Pediatric retinal photograph (wide-field).
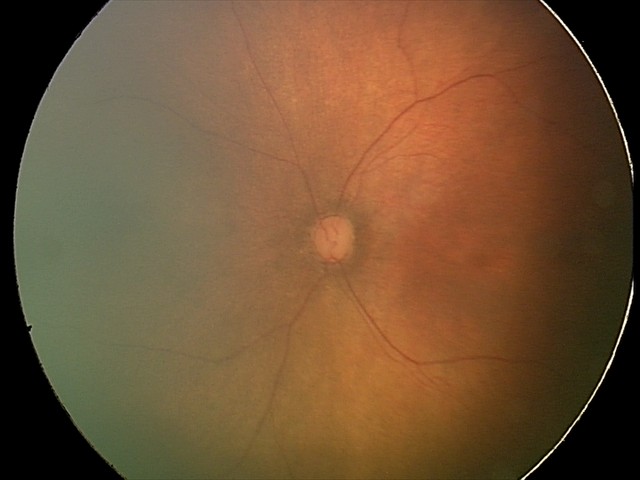

Examination with physiological retinal findings.